Phoenix ICON wide-field infant fundus image
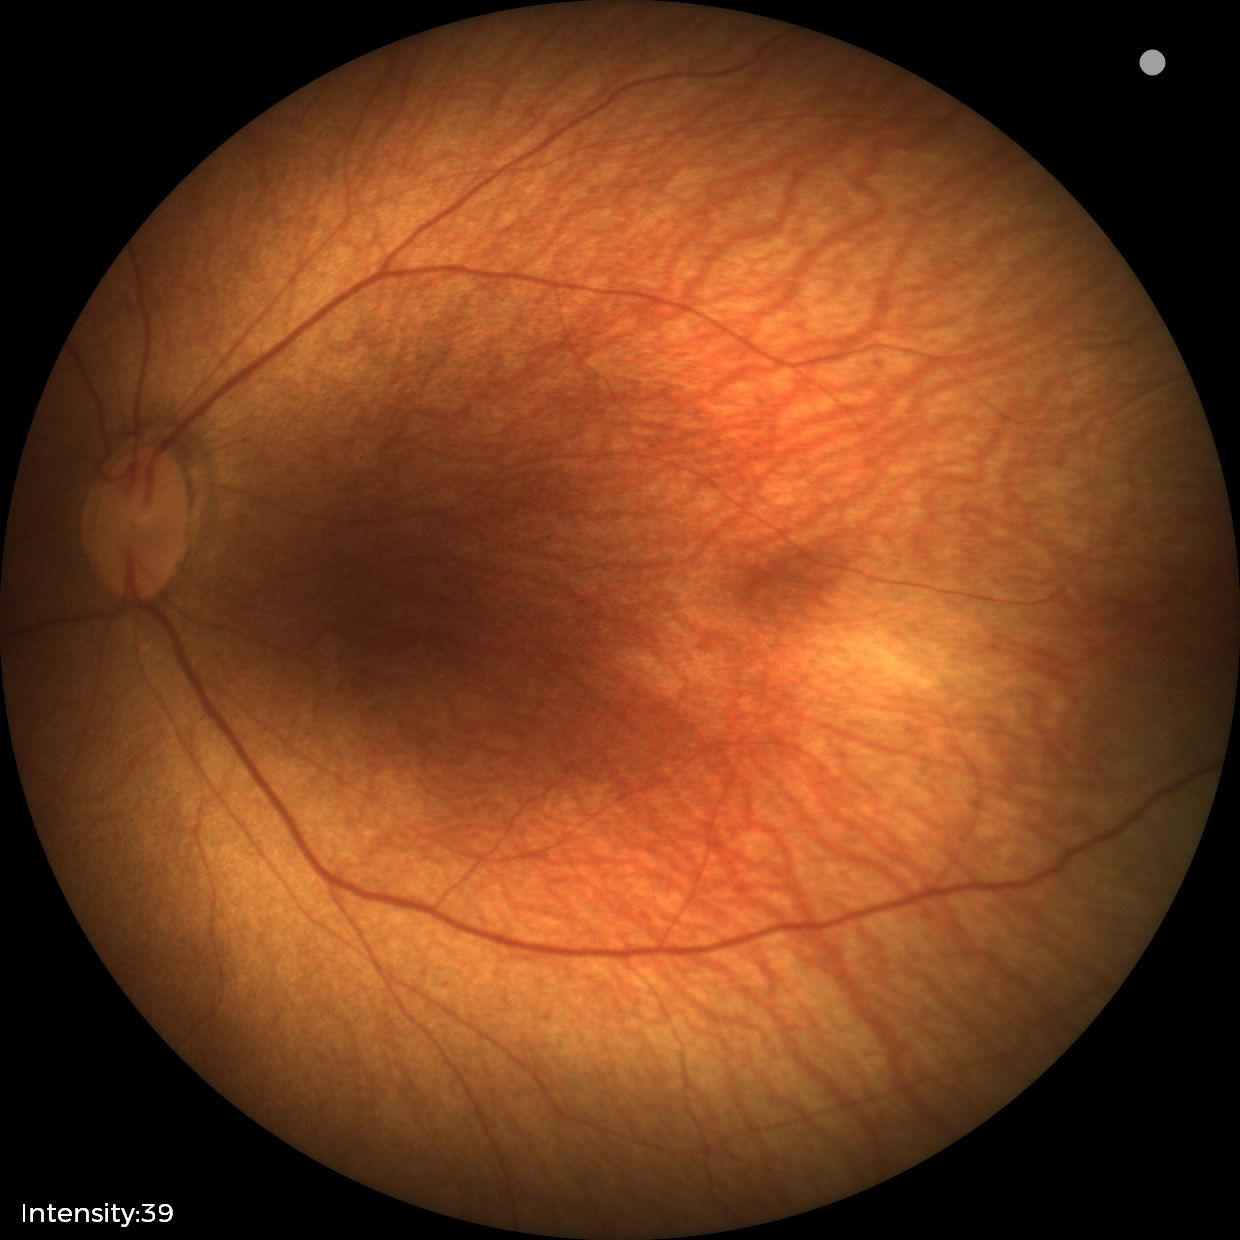 Screening examination with no abnormal retinal findings.